Modified Davis grading; nonmydriatic fundus photograph — 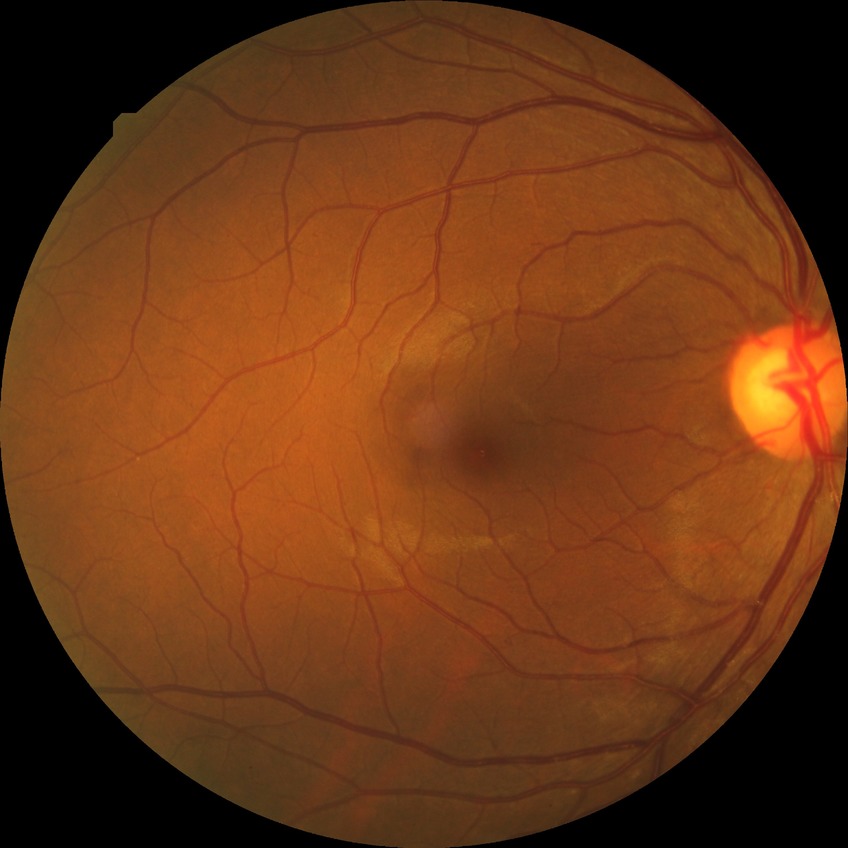

DR severity is NDR.